Macula-centered field
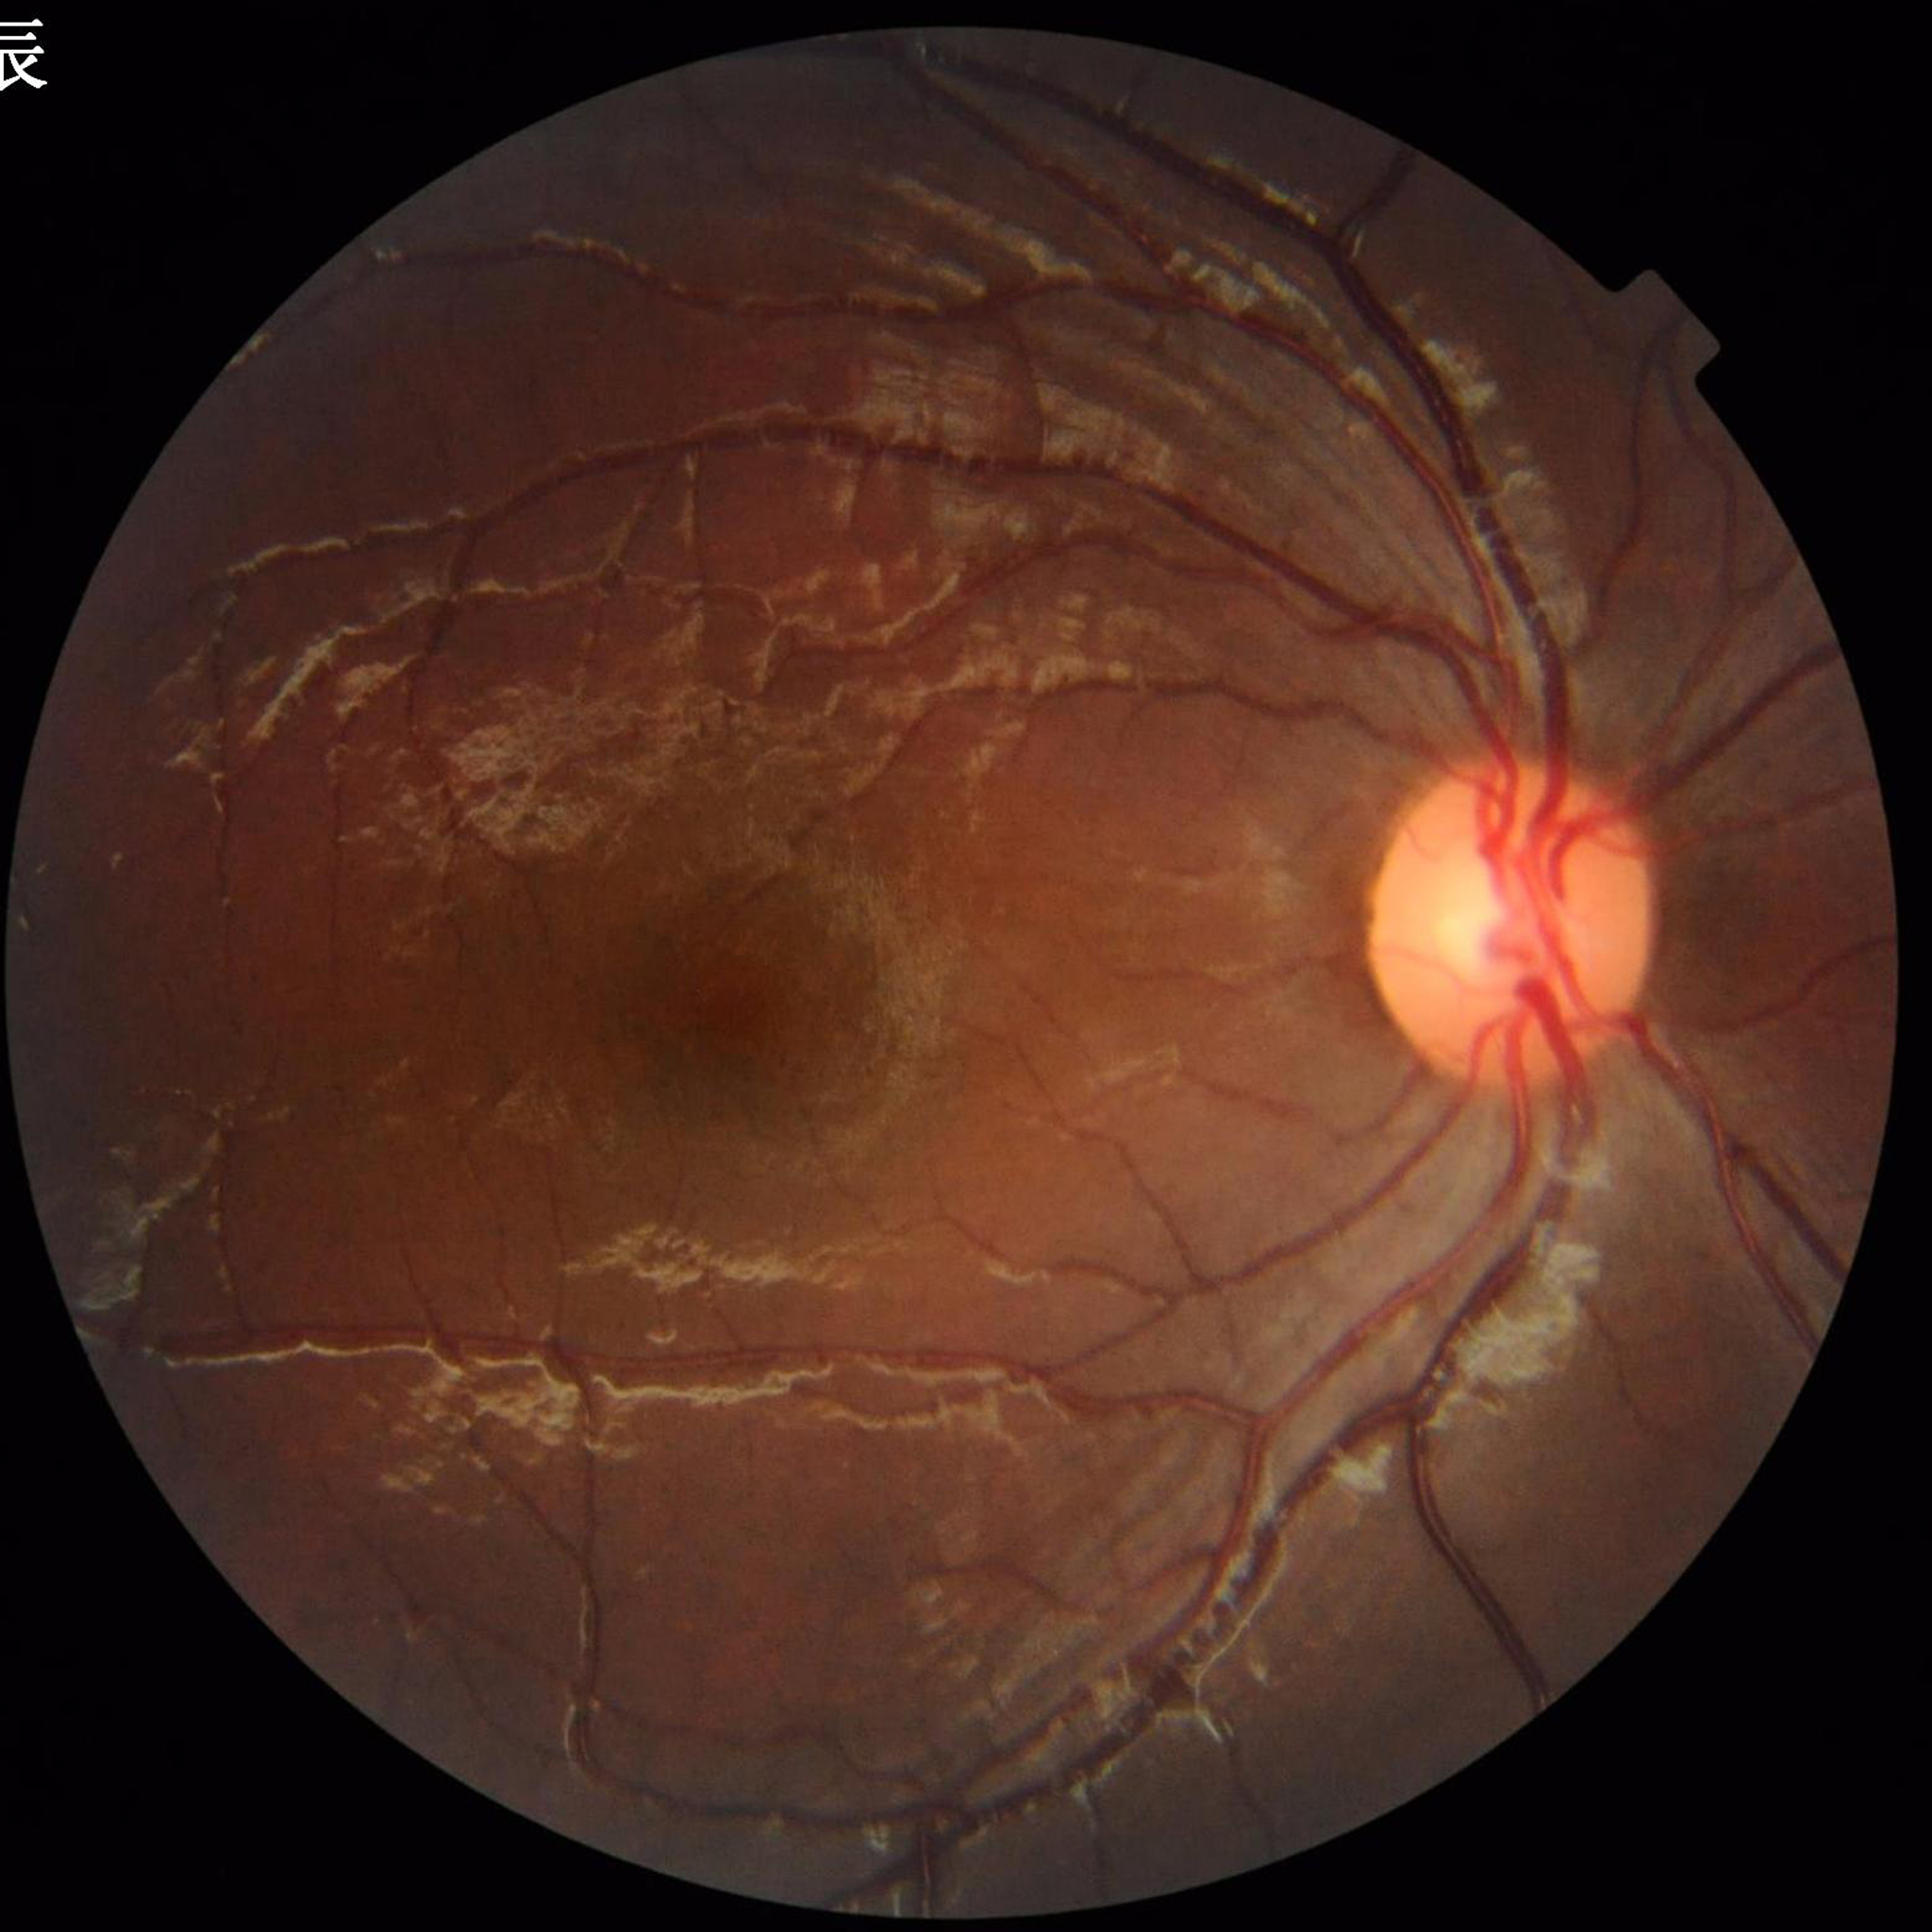 Photo quality: good. From a control without AMD, diabetic retinopathy, or glaucoma.